45 degree fundus photograph; modified Davis classification; no pharmacologic dilation: 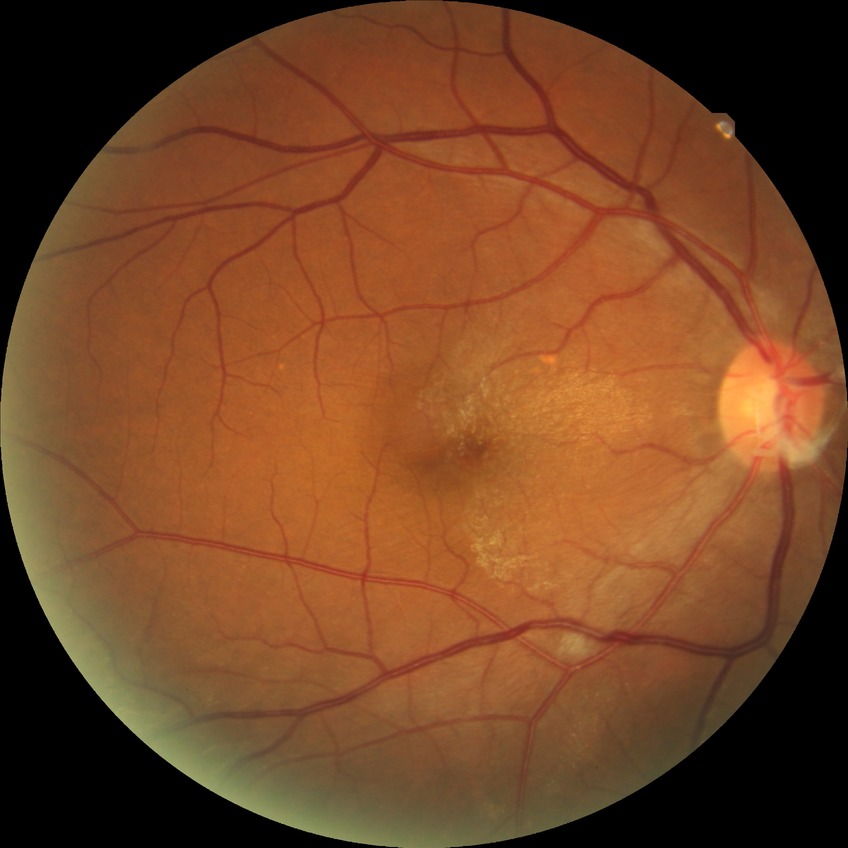 Diabetic retinopathy (DR): NDR (no diabetic retinopathy).